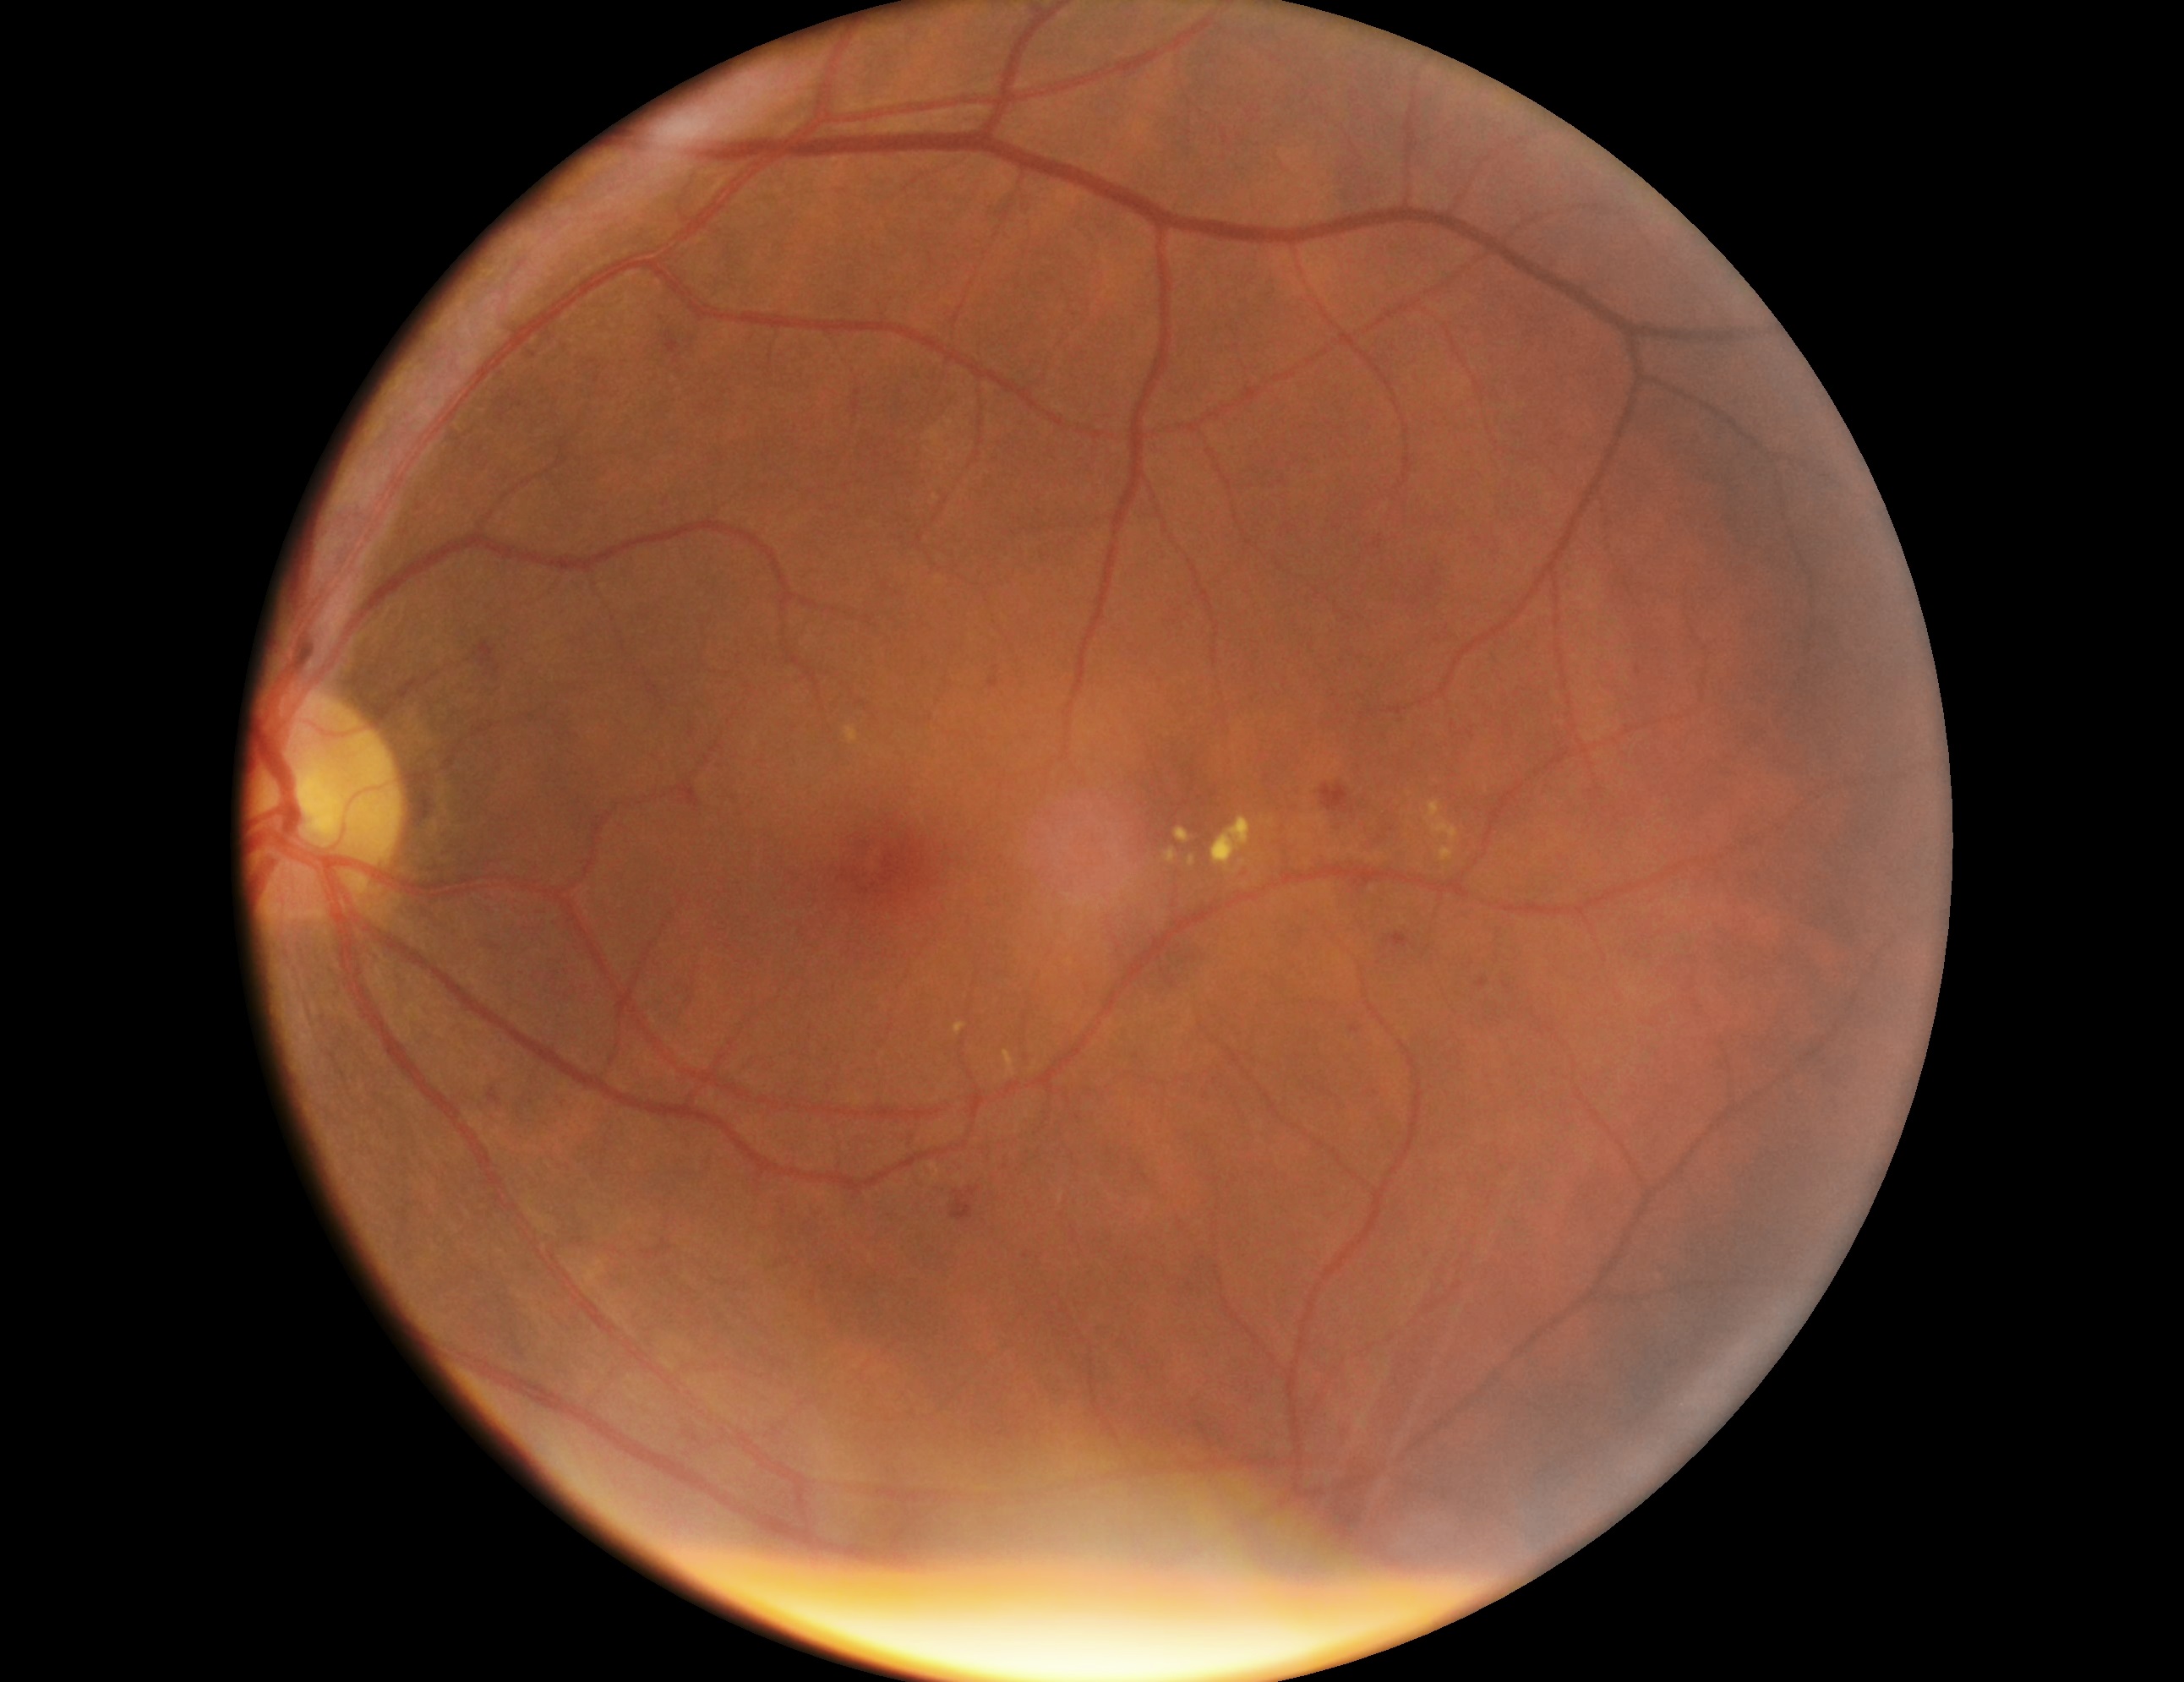

{"dr_grade": 2, "lesions": {"se": null, "he": [[665, 330, 680, 354], [481, 643, 498, 669], [1321, 784, 1355, 814], [969, 1188, 978, 1196], [951, 1191, 975, 1221]], "he_small_approx": [[498, 669]], "ex": [[1166, 848, 1177, 865], [956, 1024, 968, 1035], [1003, 1051, 1015, 1078], [844, 728, 858, 745], [1424, 800, 1460, 844], [1189, 856, 1196, 868], [1439, 848, 1455, 863], [1176, 827, 1193, 844], [1211, 817, 1252, 875]], "ma": [[1477, 978, 1487, 988], [1351, 1027, 1360, 1034], [990, 677, 998, 689], [488, 1089, 501, 1105], [1387, 934, 1411, 949]], "ma_small_approx": [[995, 668], [1638, 672]]}}